2352x1568: 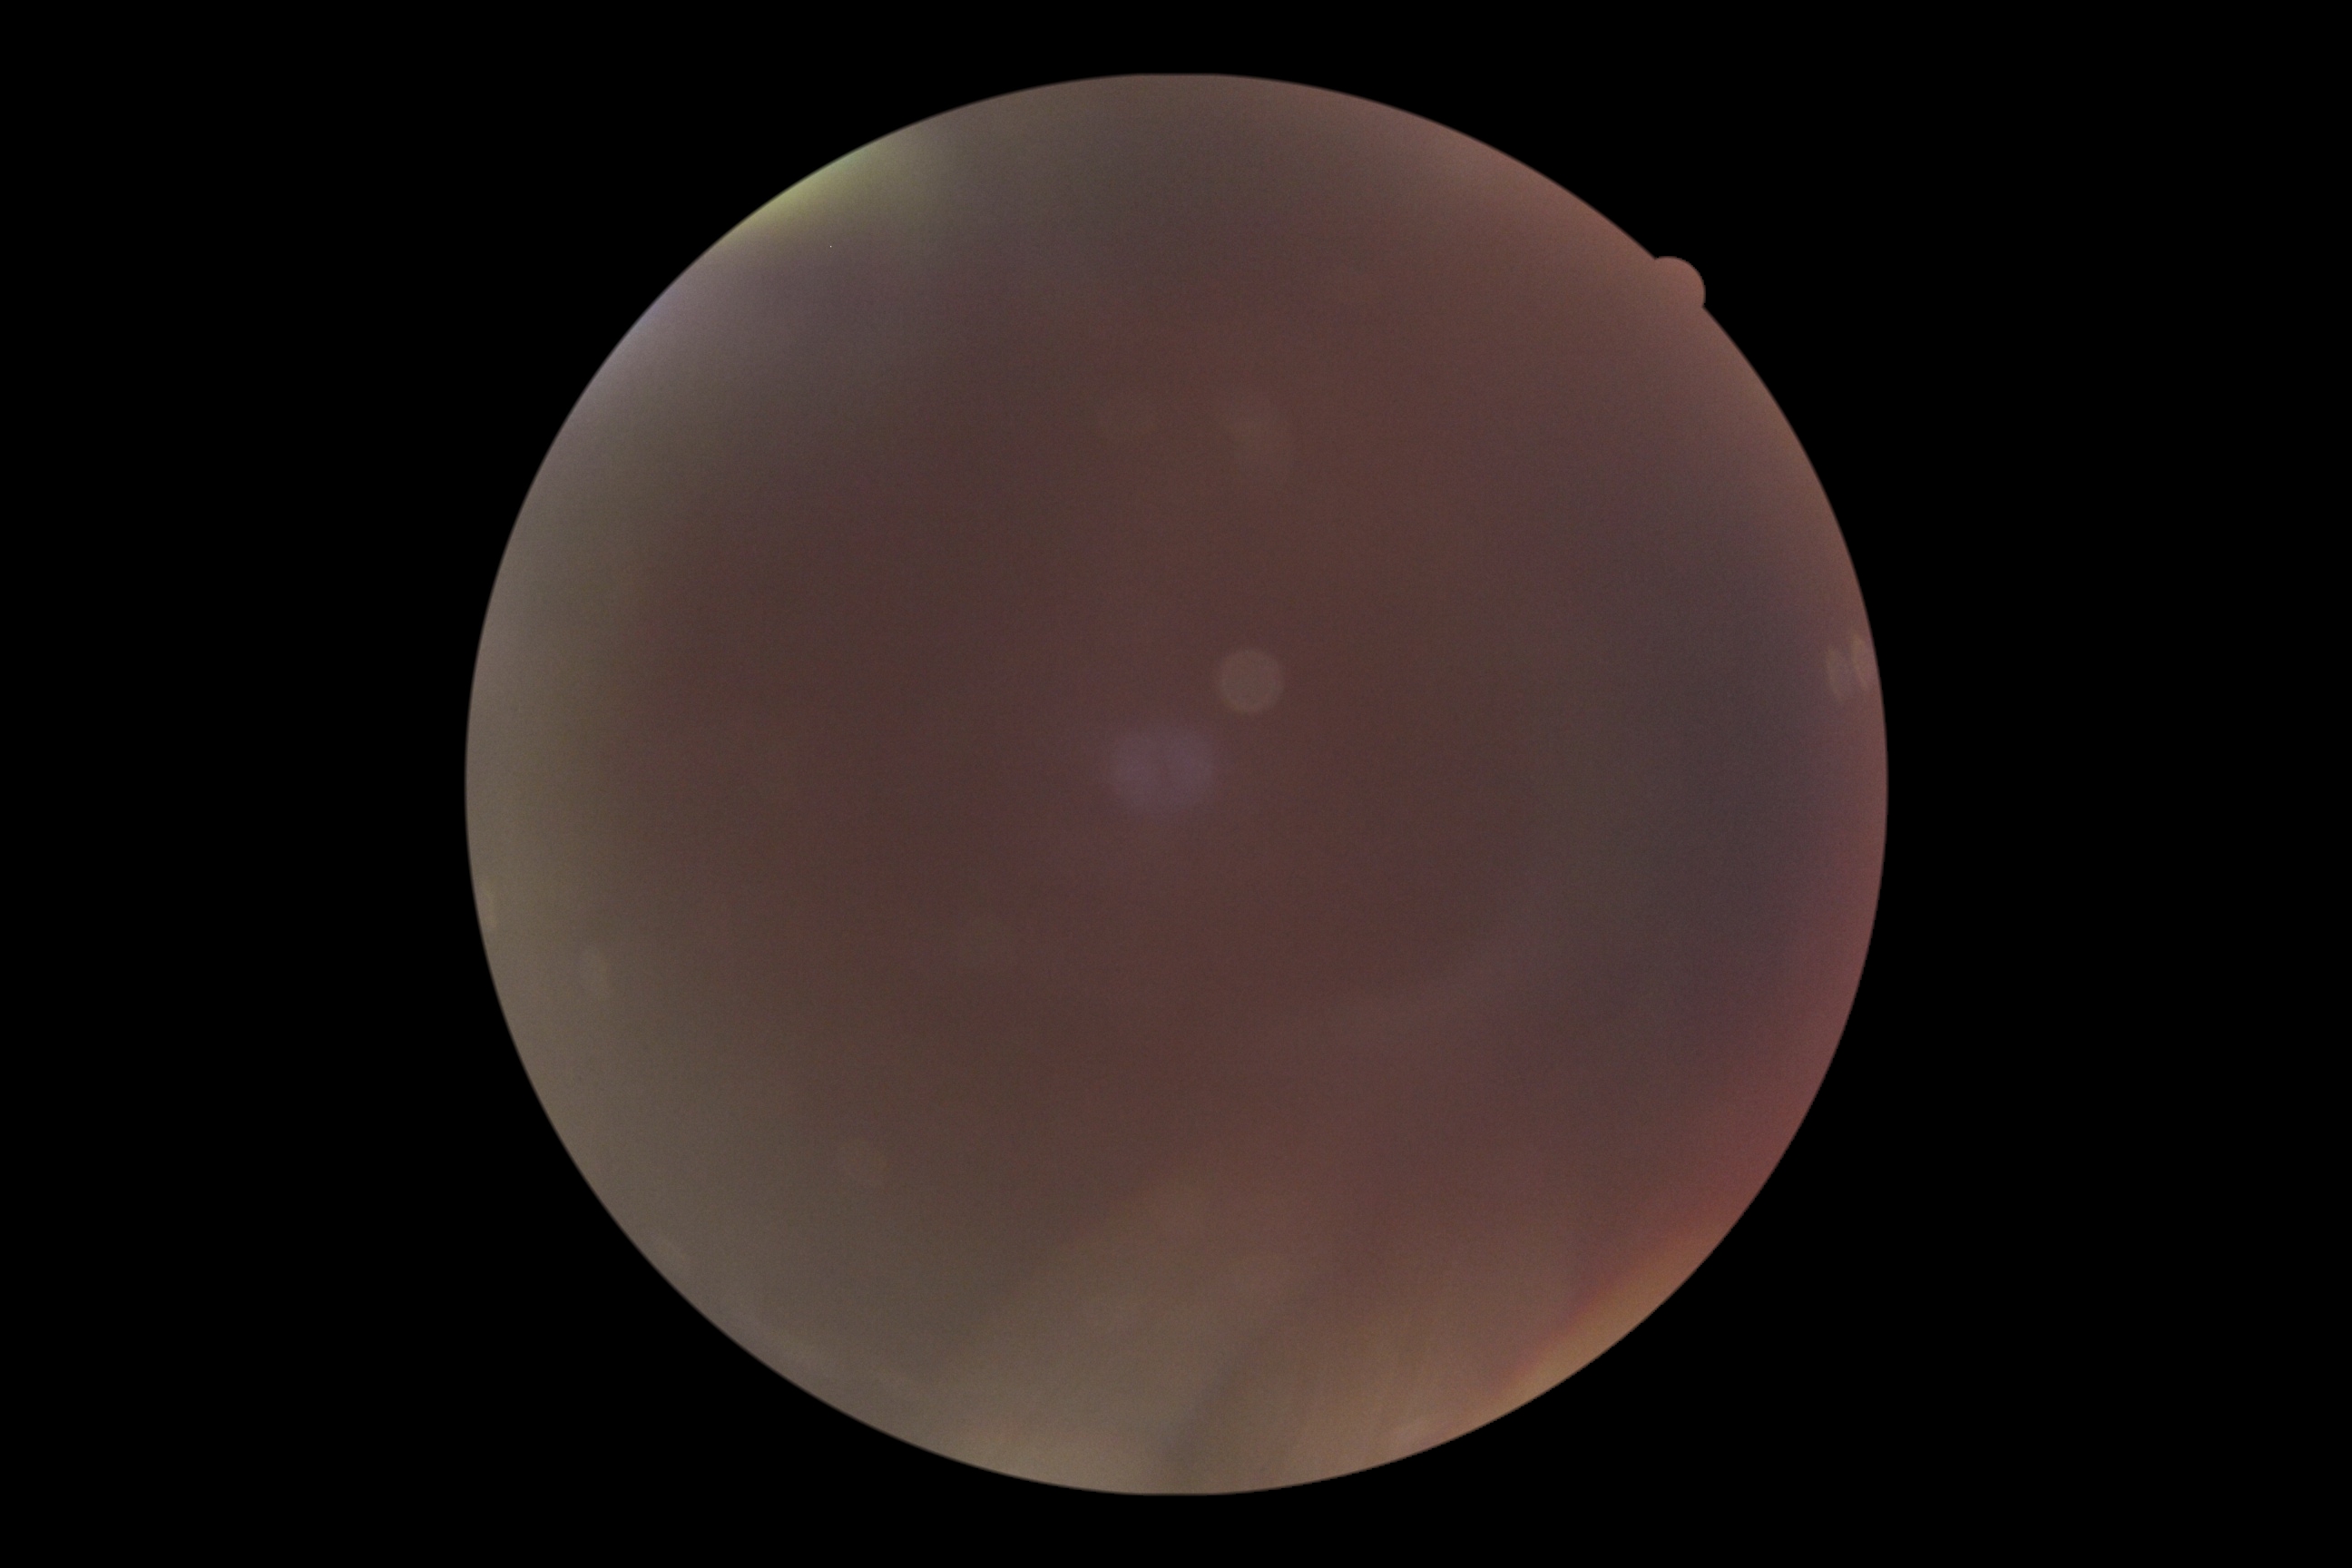
DR is ungradable.